1659 x 2212 pixels. Acquired with a Remidio Fundus on Phone (FOP) camera. Fundus photo — 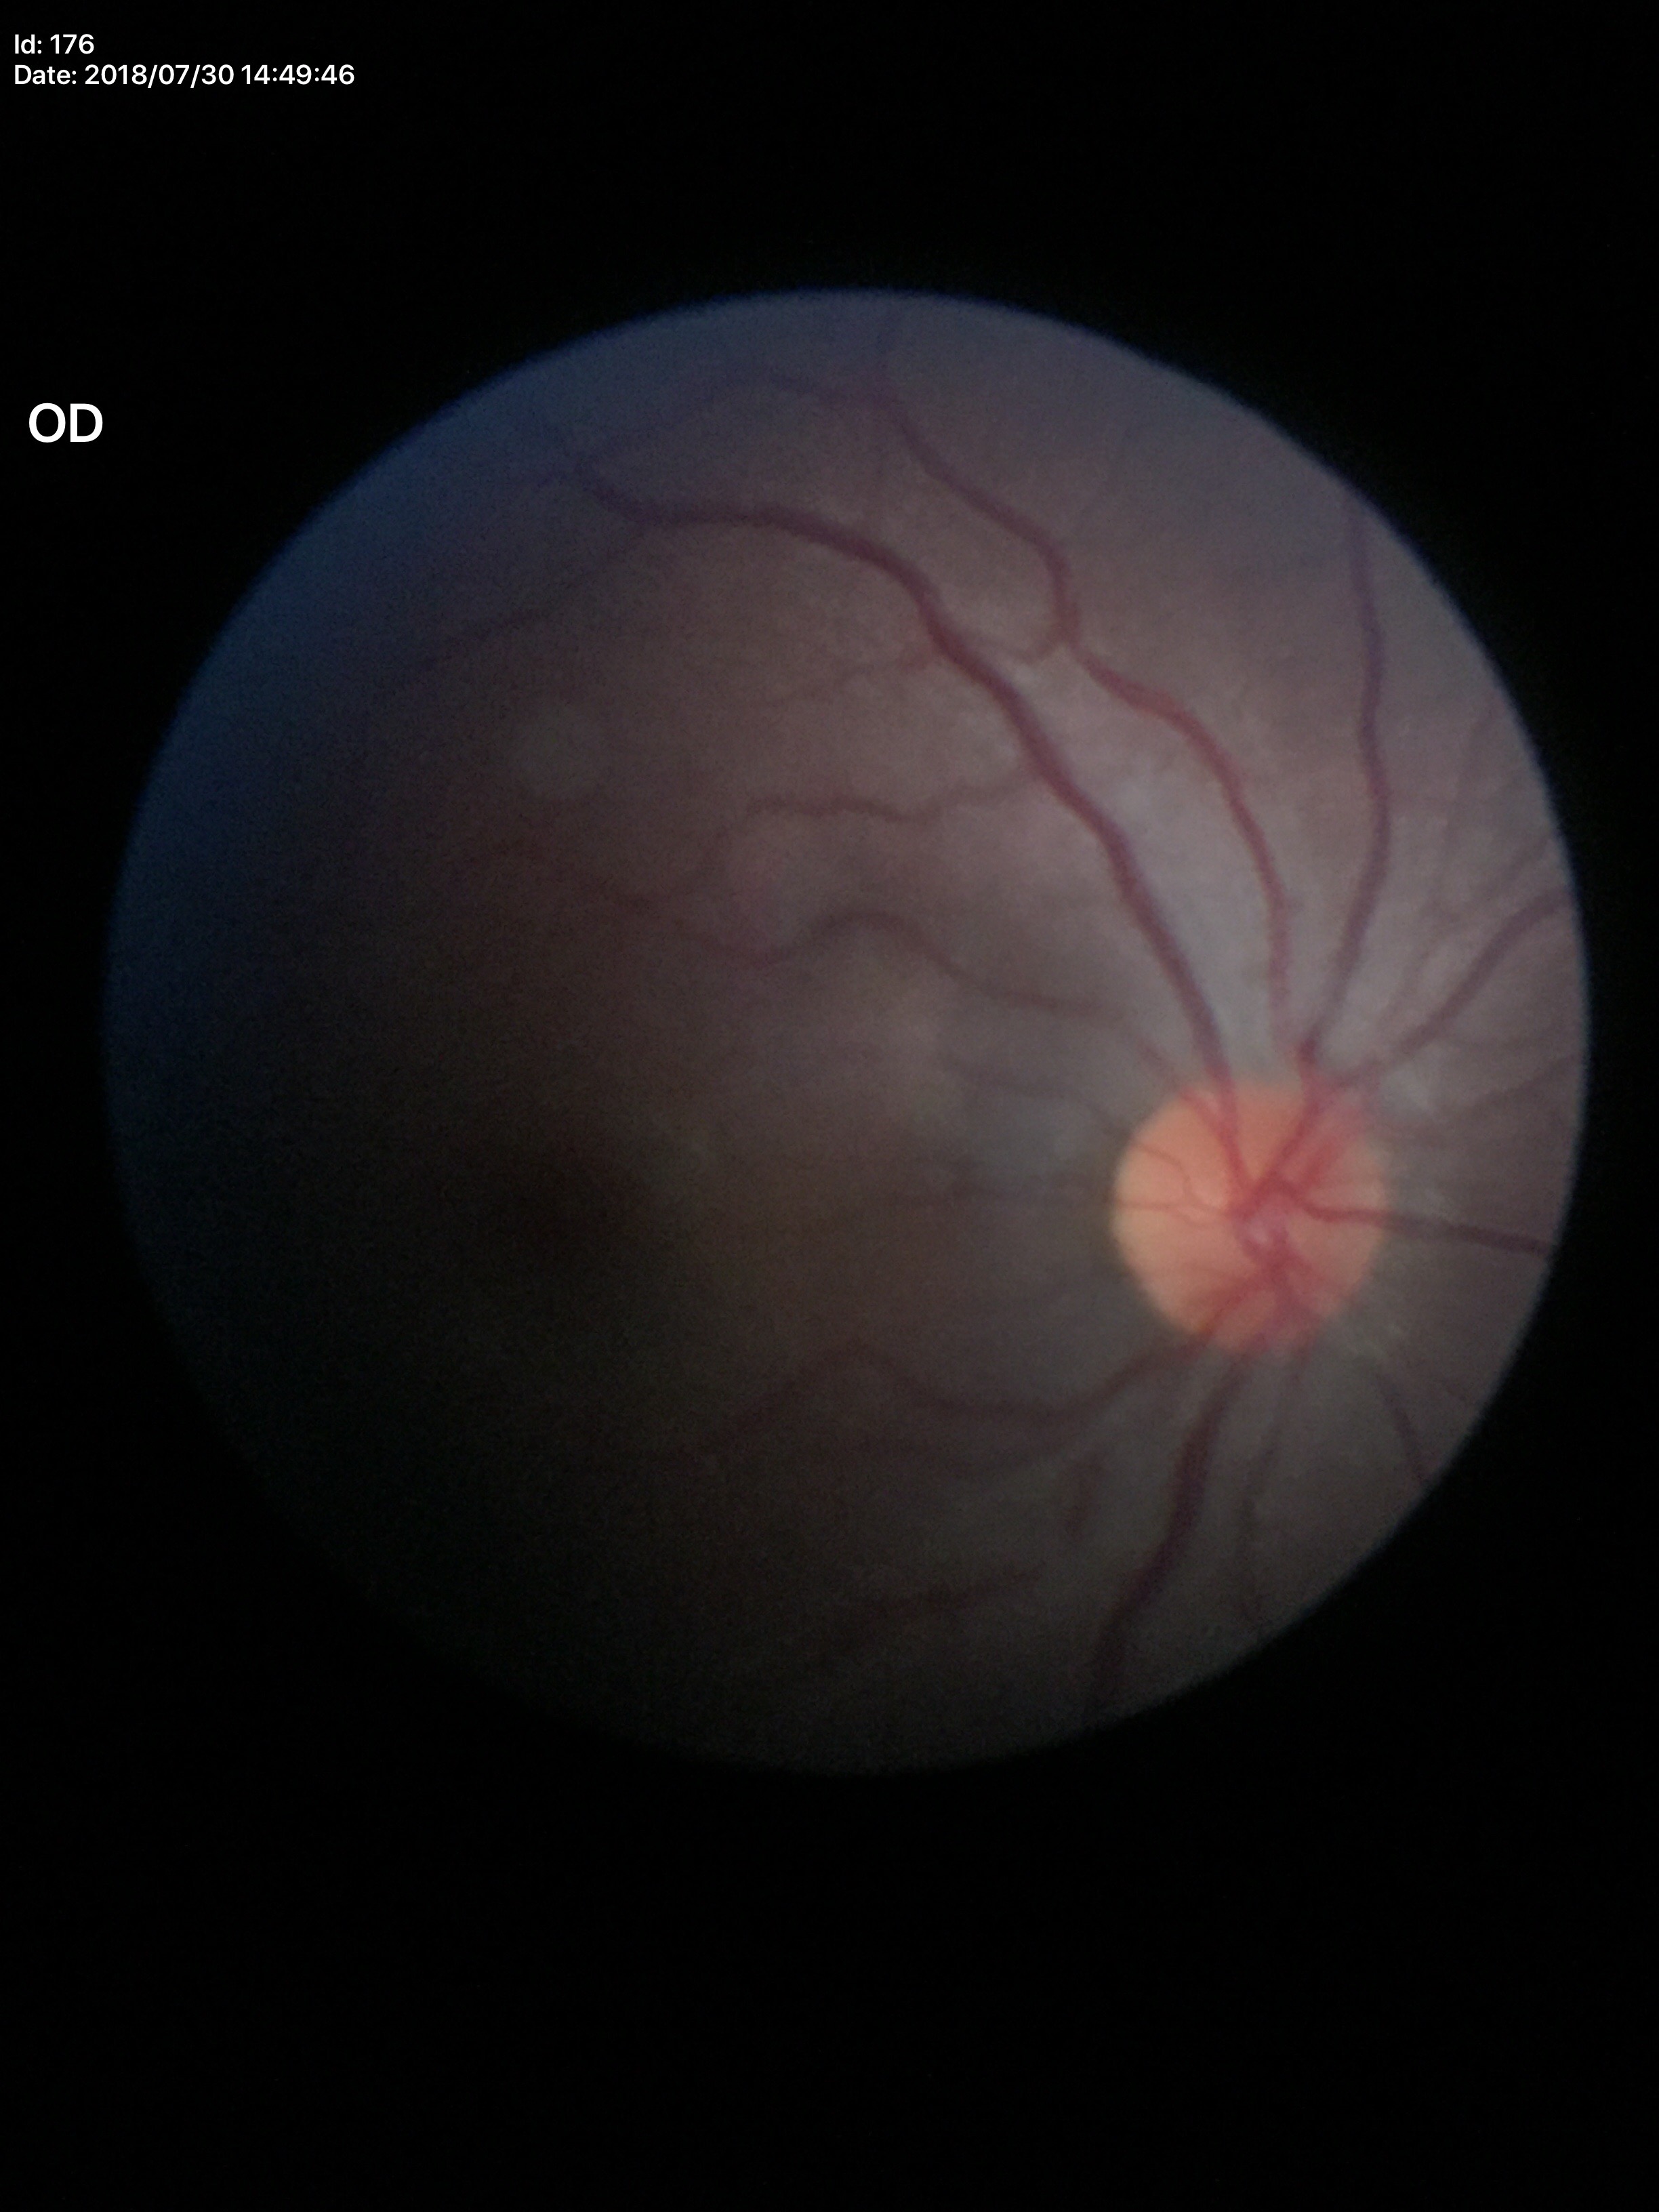

horizontal CDR (HCDR) = 0.43; vertical C/D ratio (VCDR) = 0.44; Glaucoma decision = no suspicious findings.